Wide-field contact fundus photograph of an infant. Phoenix ICON, 100° FOV. 1240x1240px
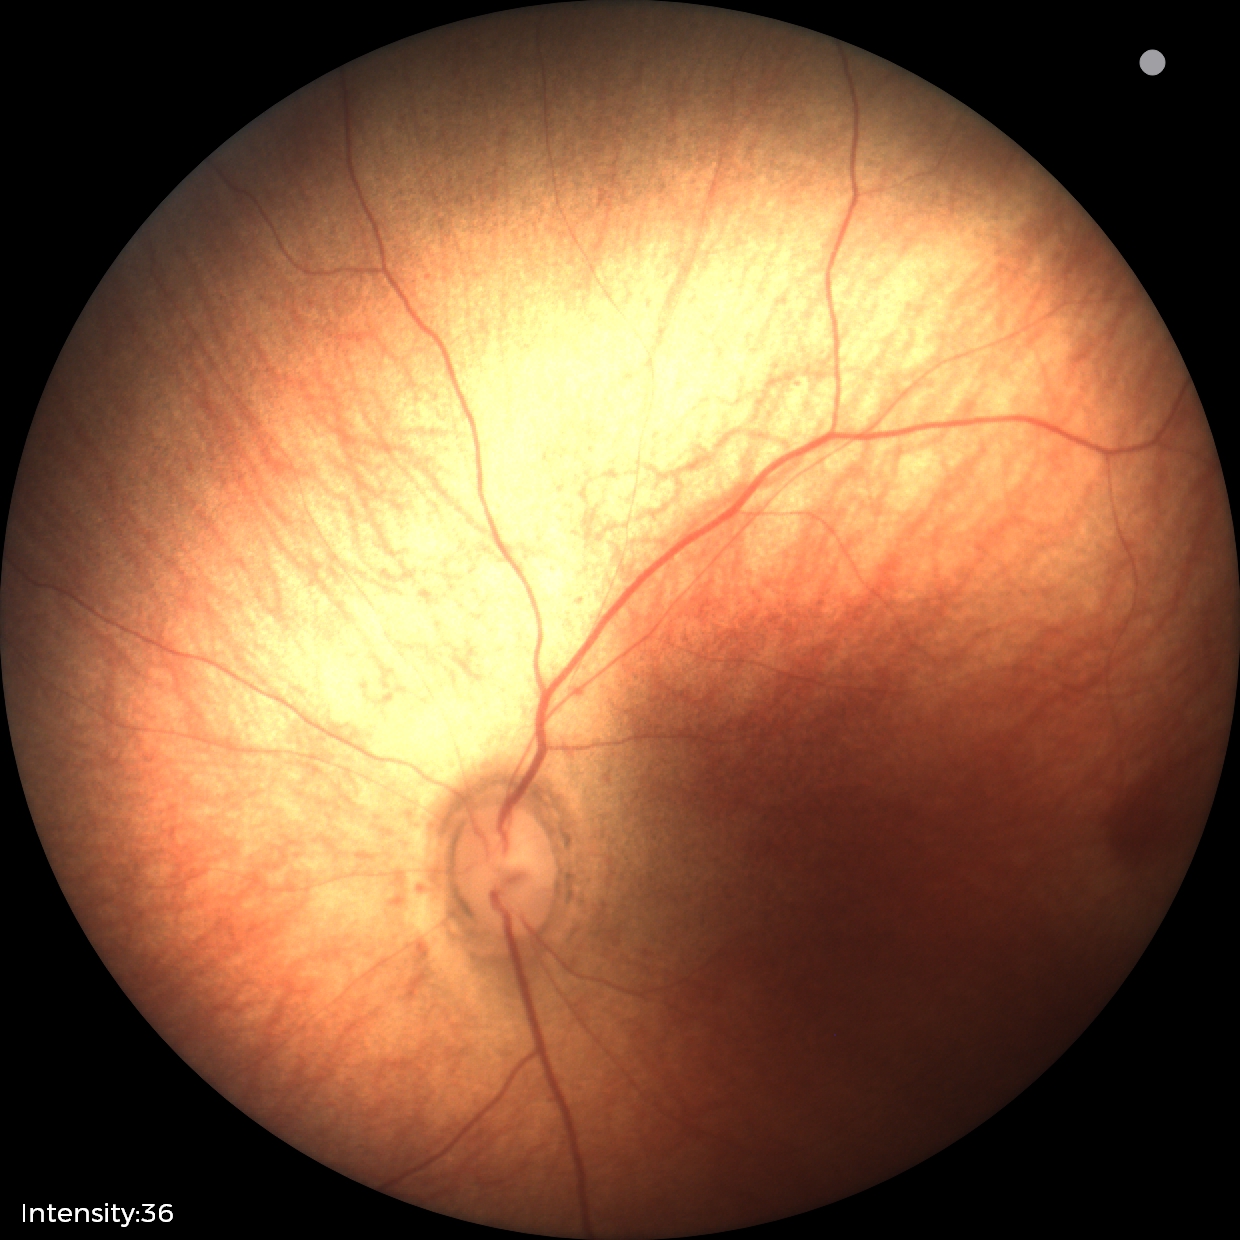

Impression: normal